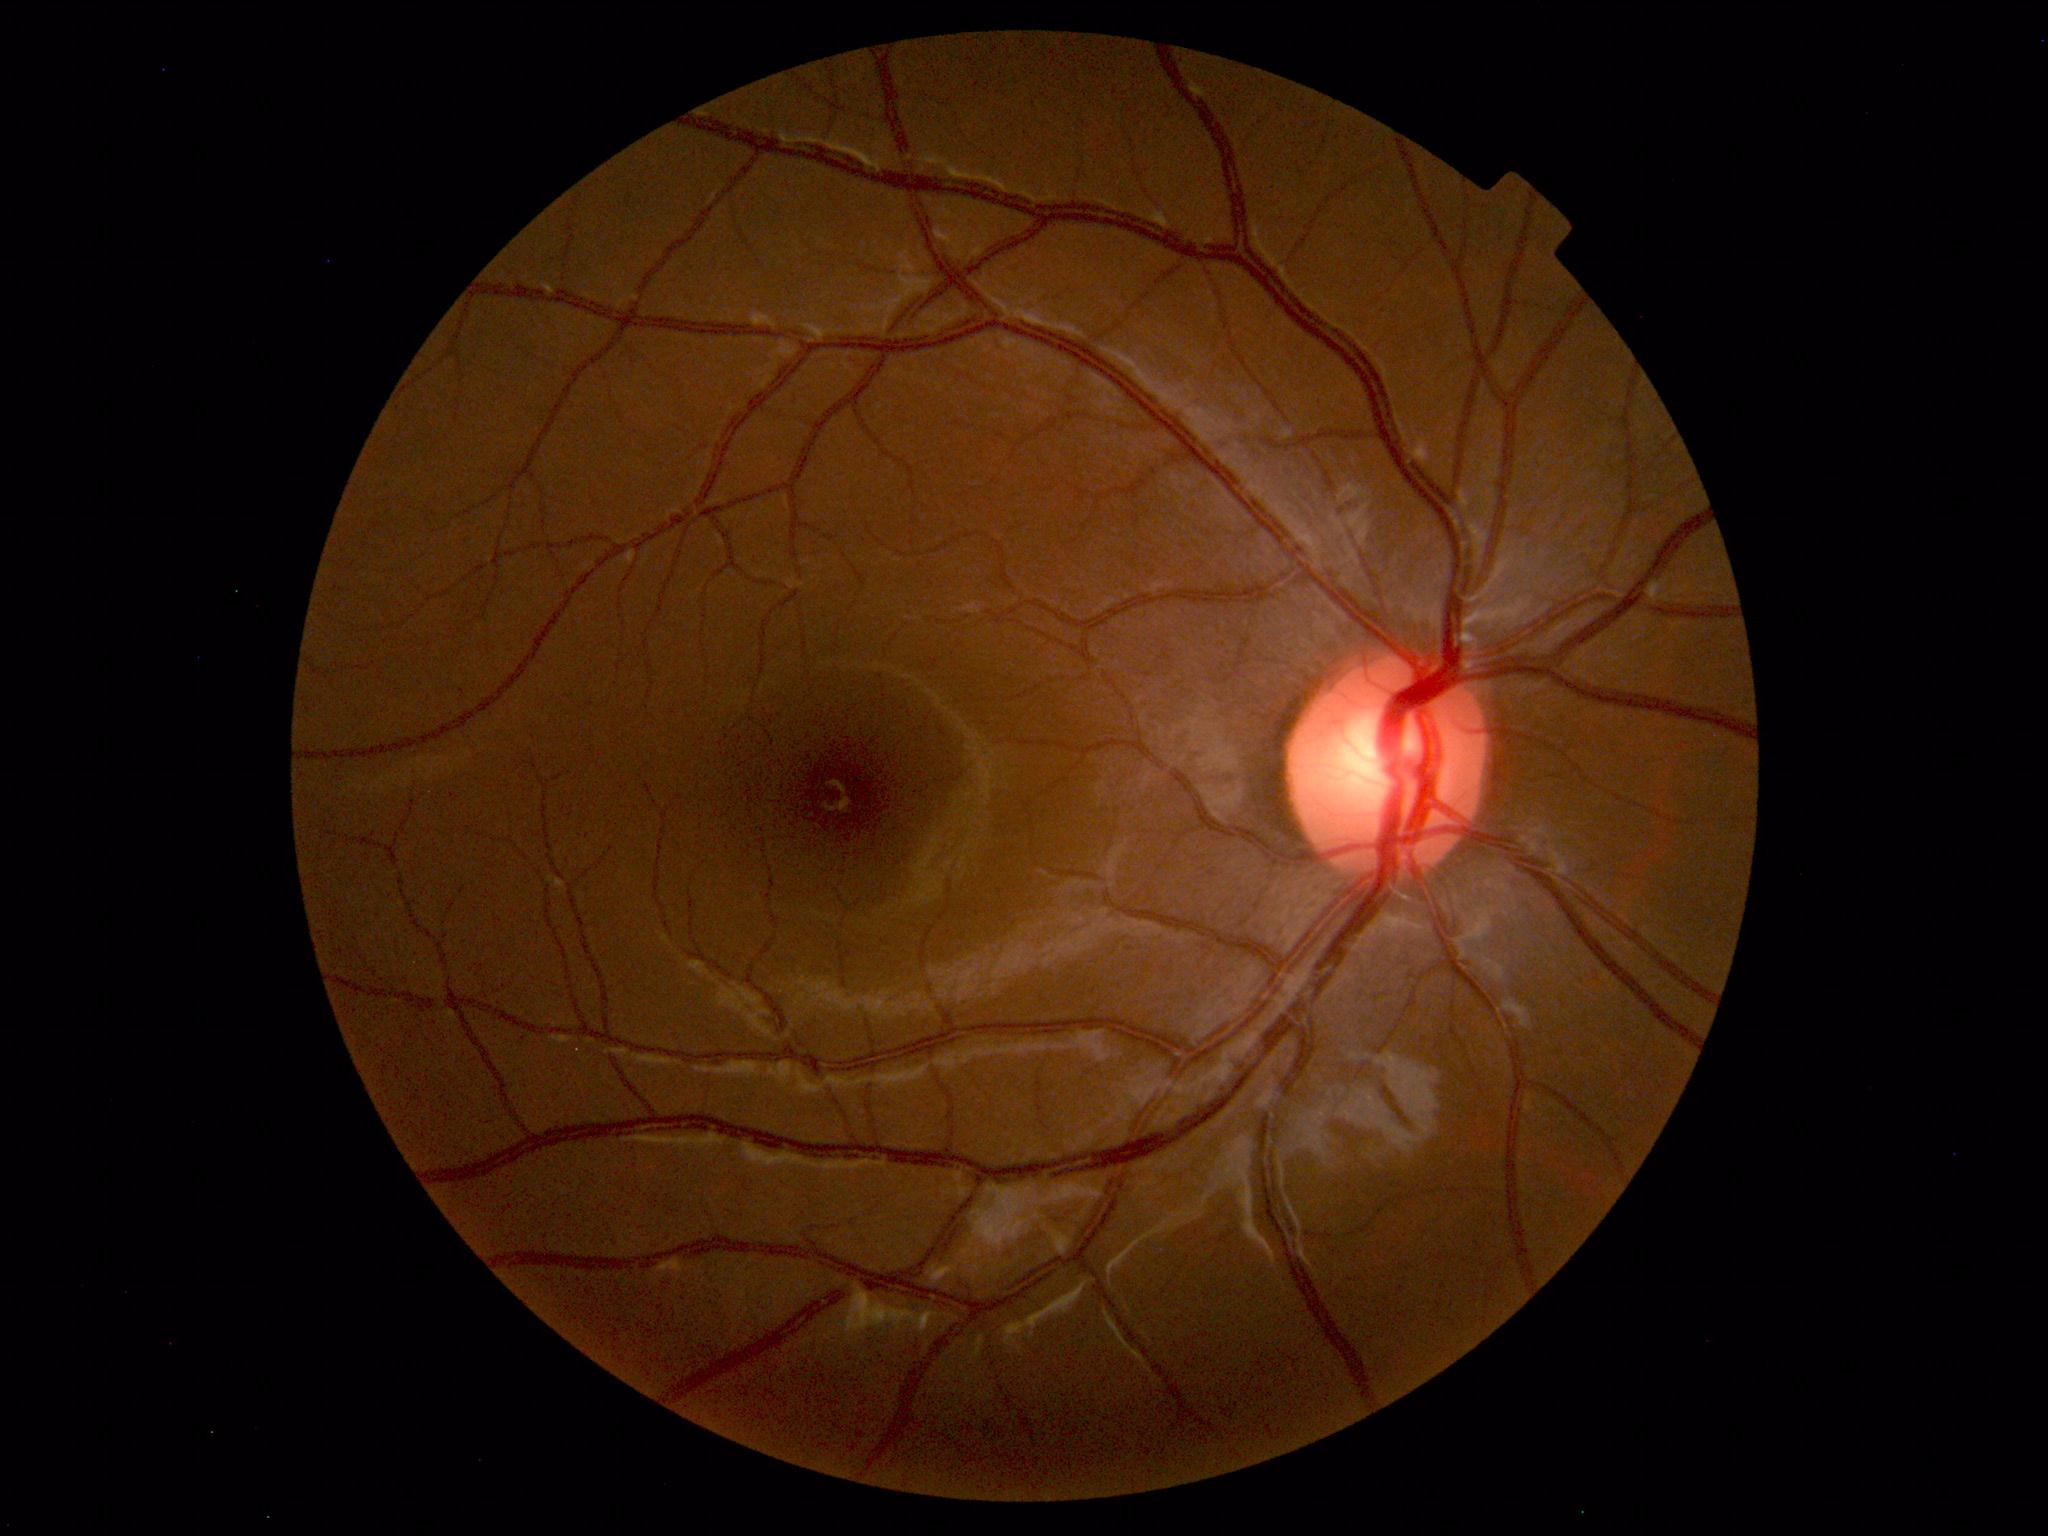
Unremarkable color fundus photograph.